FOV: 45 degrees. Color fundus photograph. 2346x1568
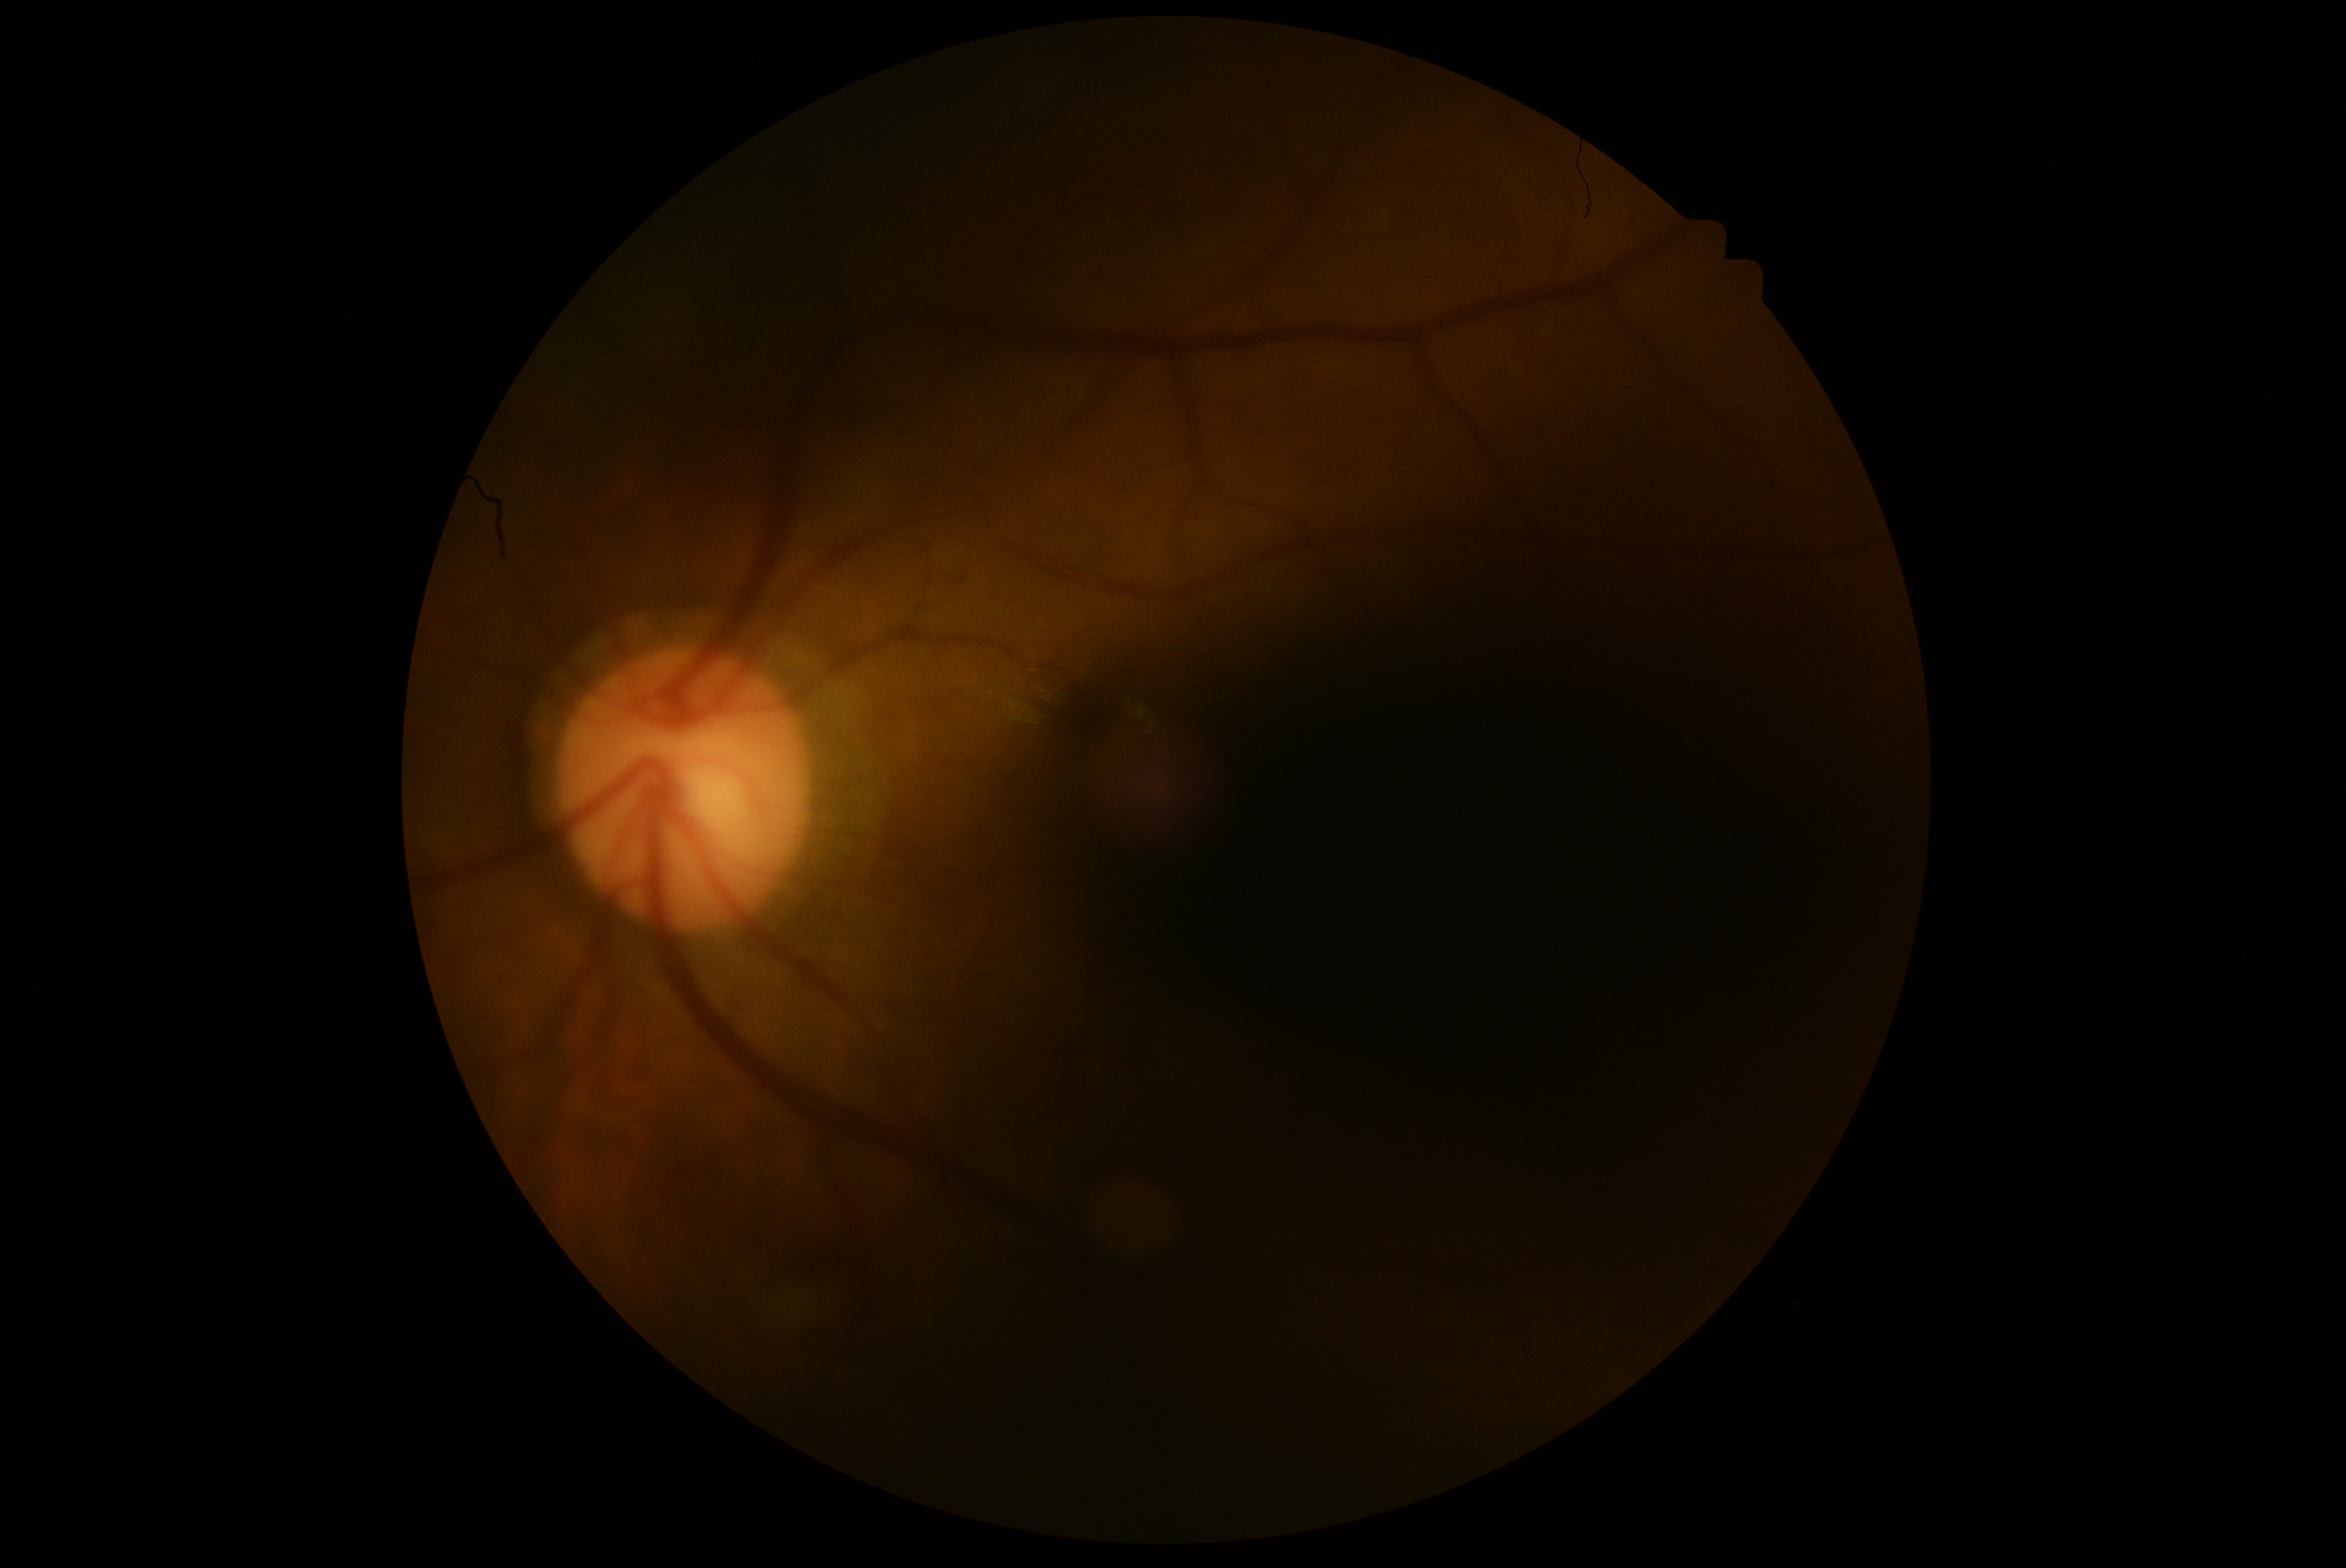

Diabetic retinopathy severity is ungradable.
The image cannot be graded for diabetic retinopathy.